Clarity RetCam 3, 130° FOV; wide-field contact fundus photograph of an infant:
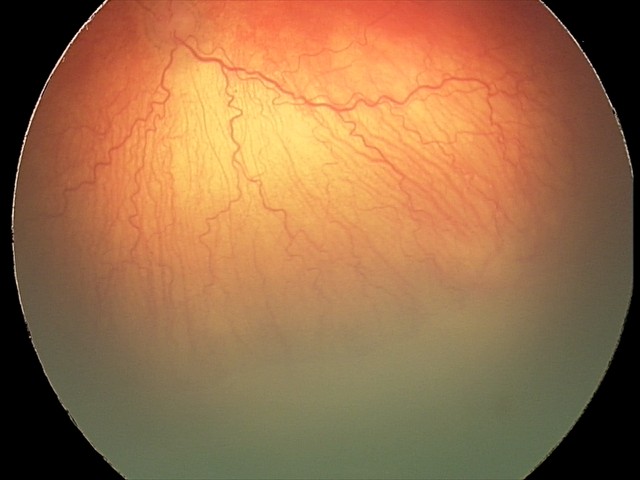 Plus disease present. Series diagnosed as aggressive retinopathy of prematurity.